Retinal fundus photograph:
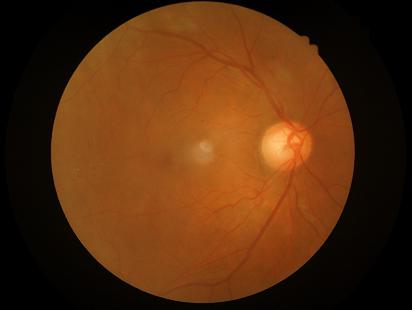

illumination: adequate
contrast: good
clarity: sharp
overall_quality: adequate